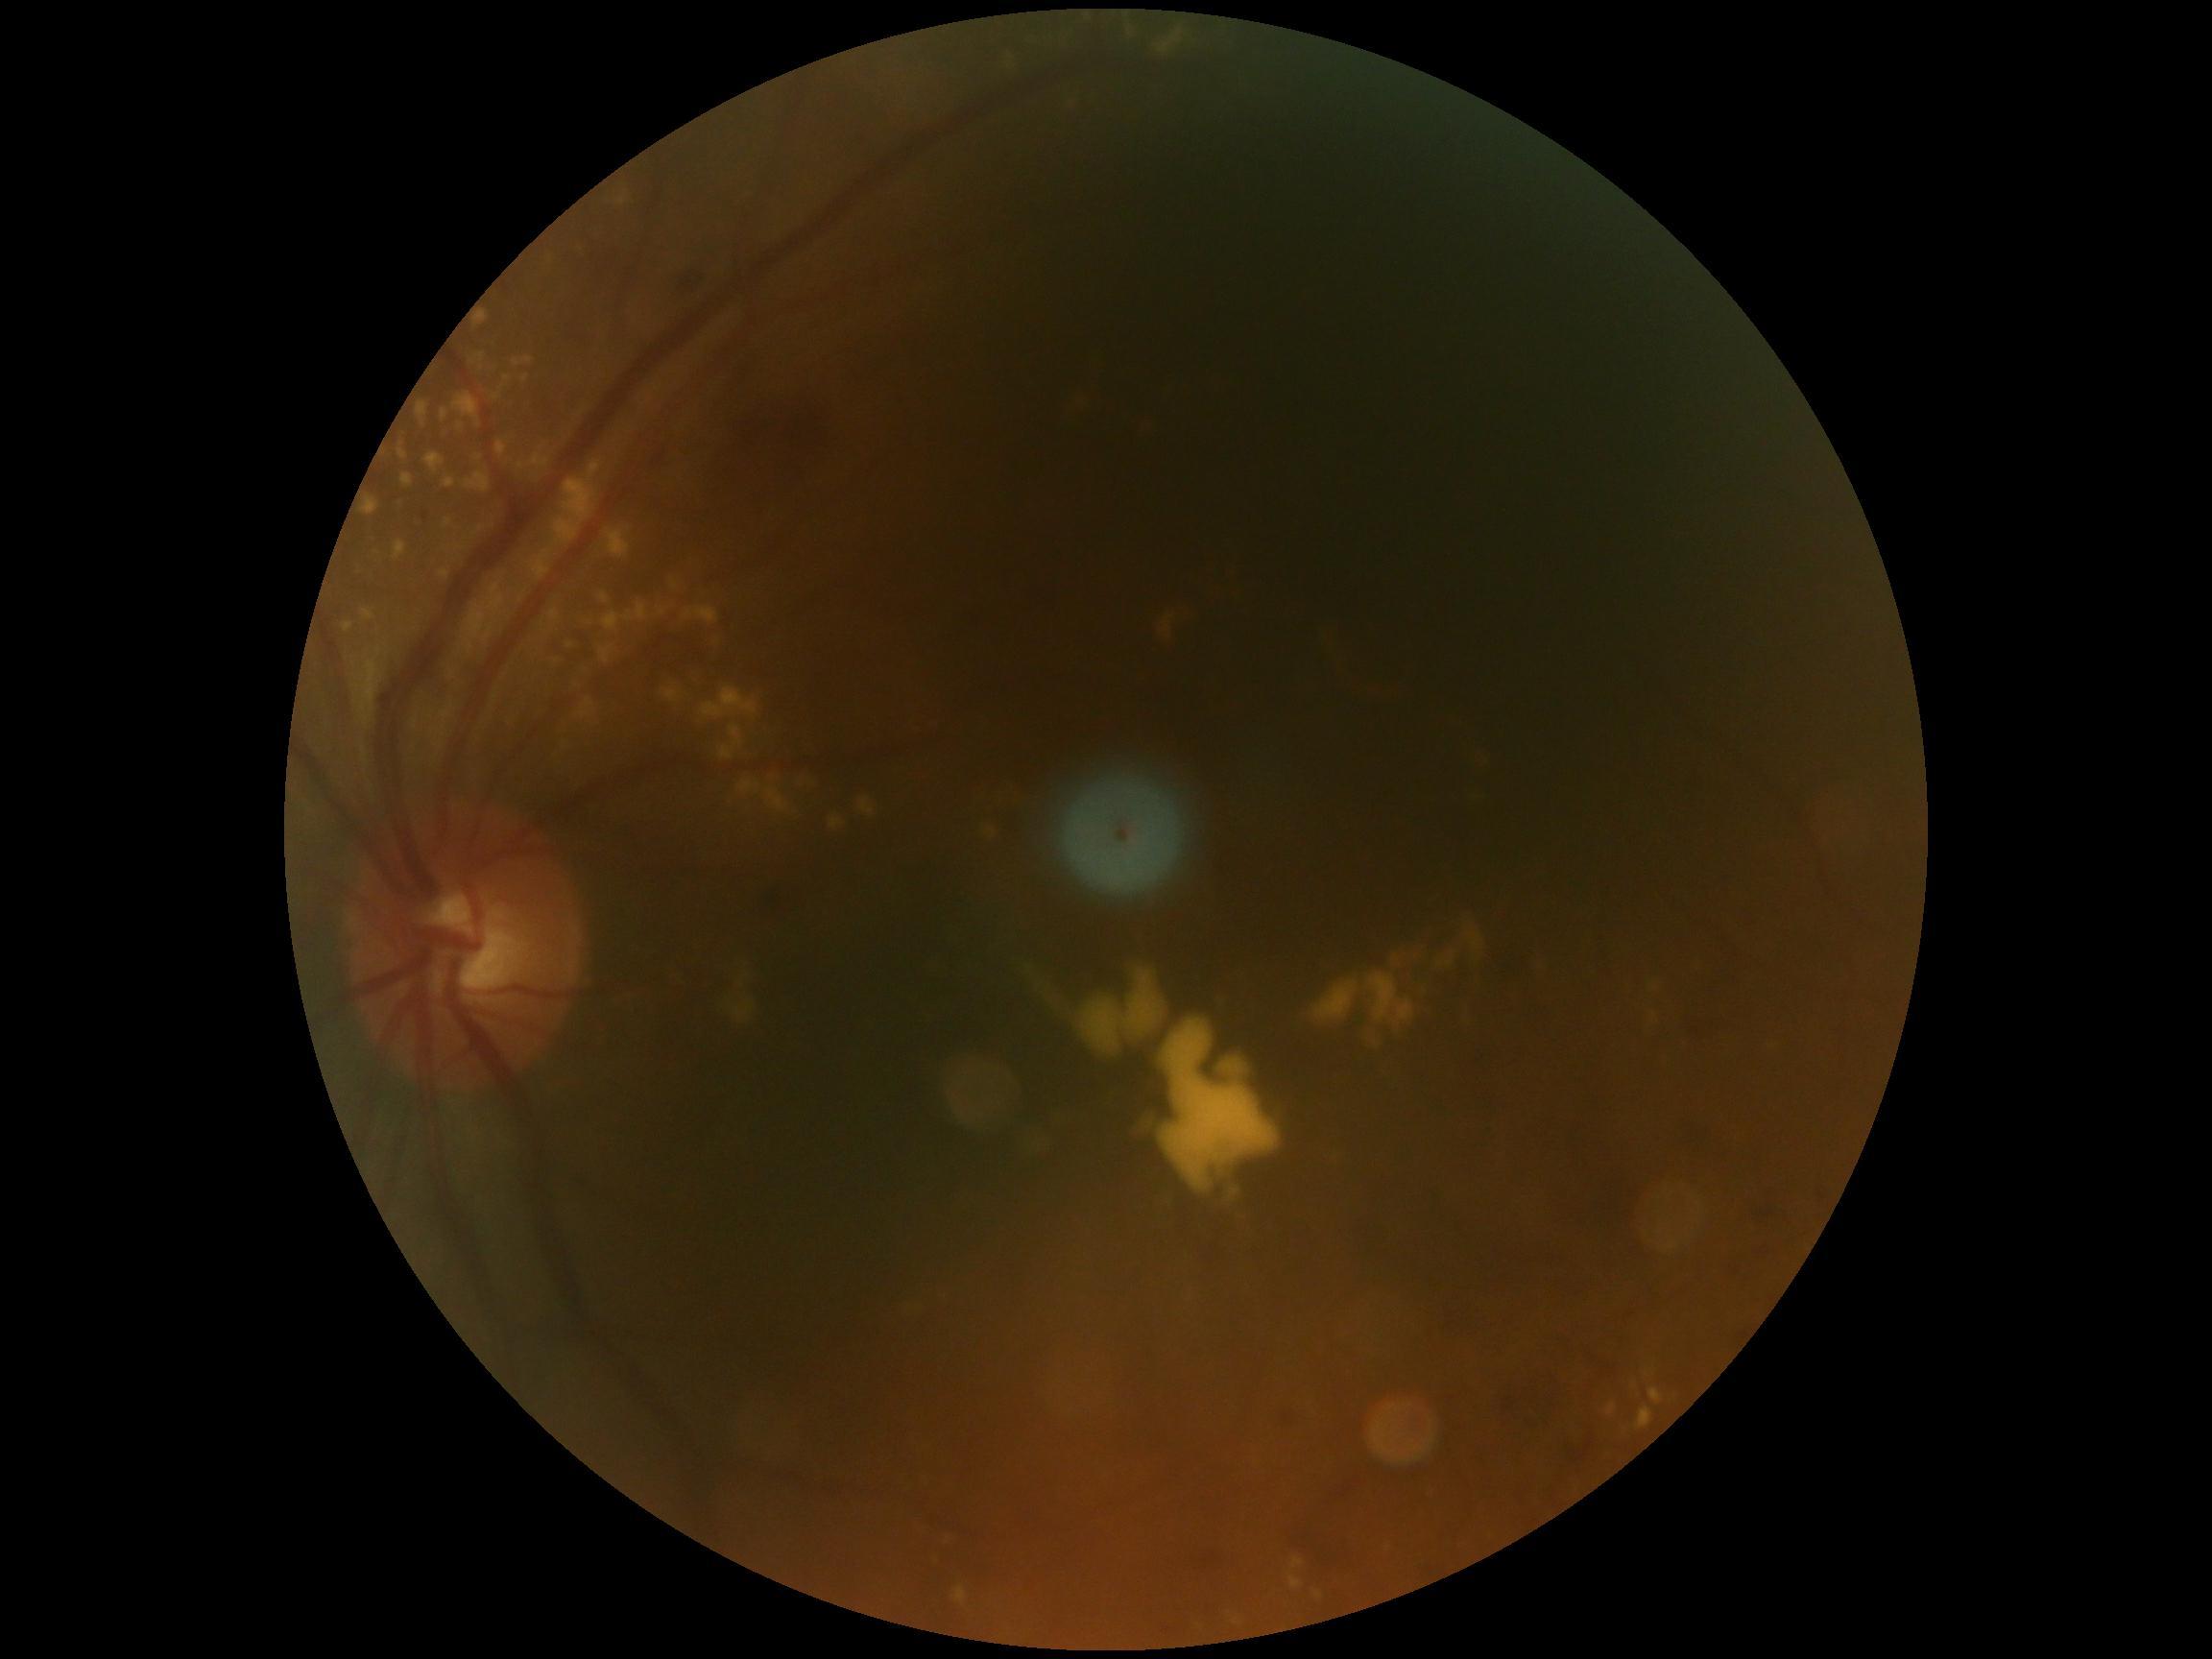
DR grade: moderate NPDR (2) — more than just microaneurysms but less than severe NPDR.